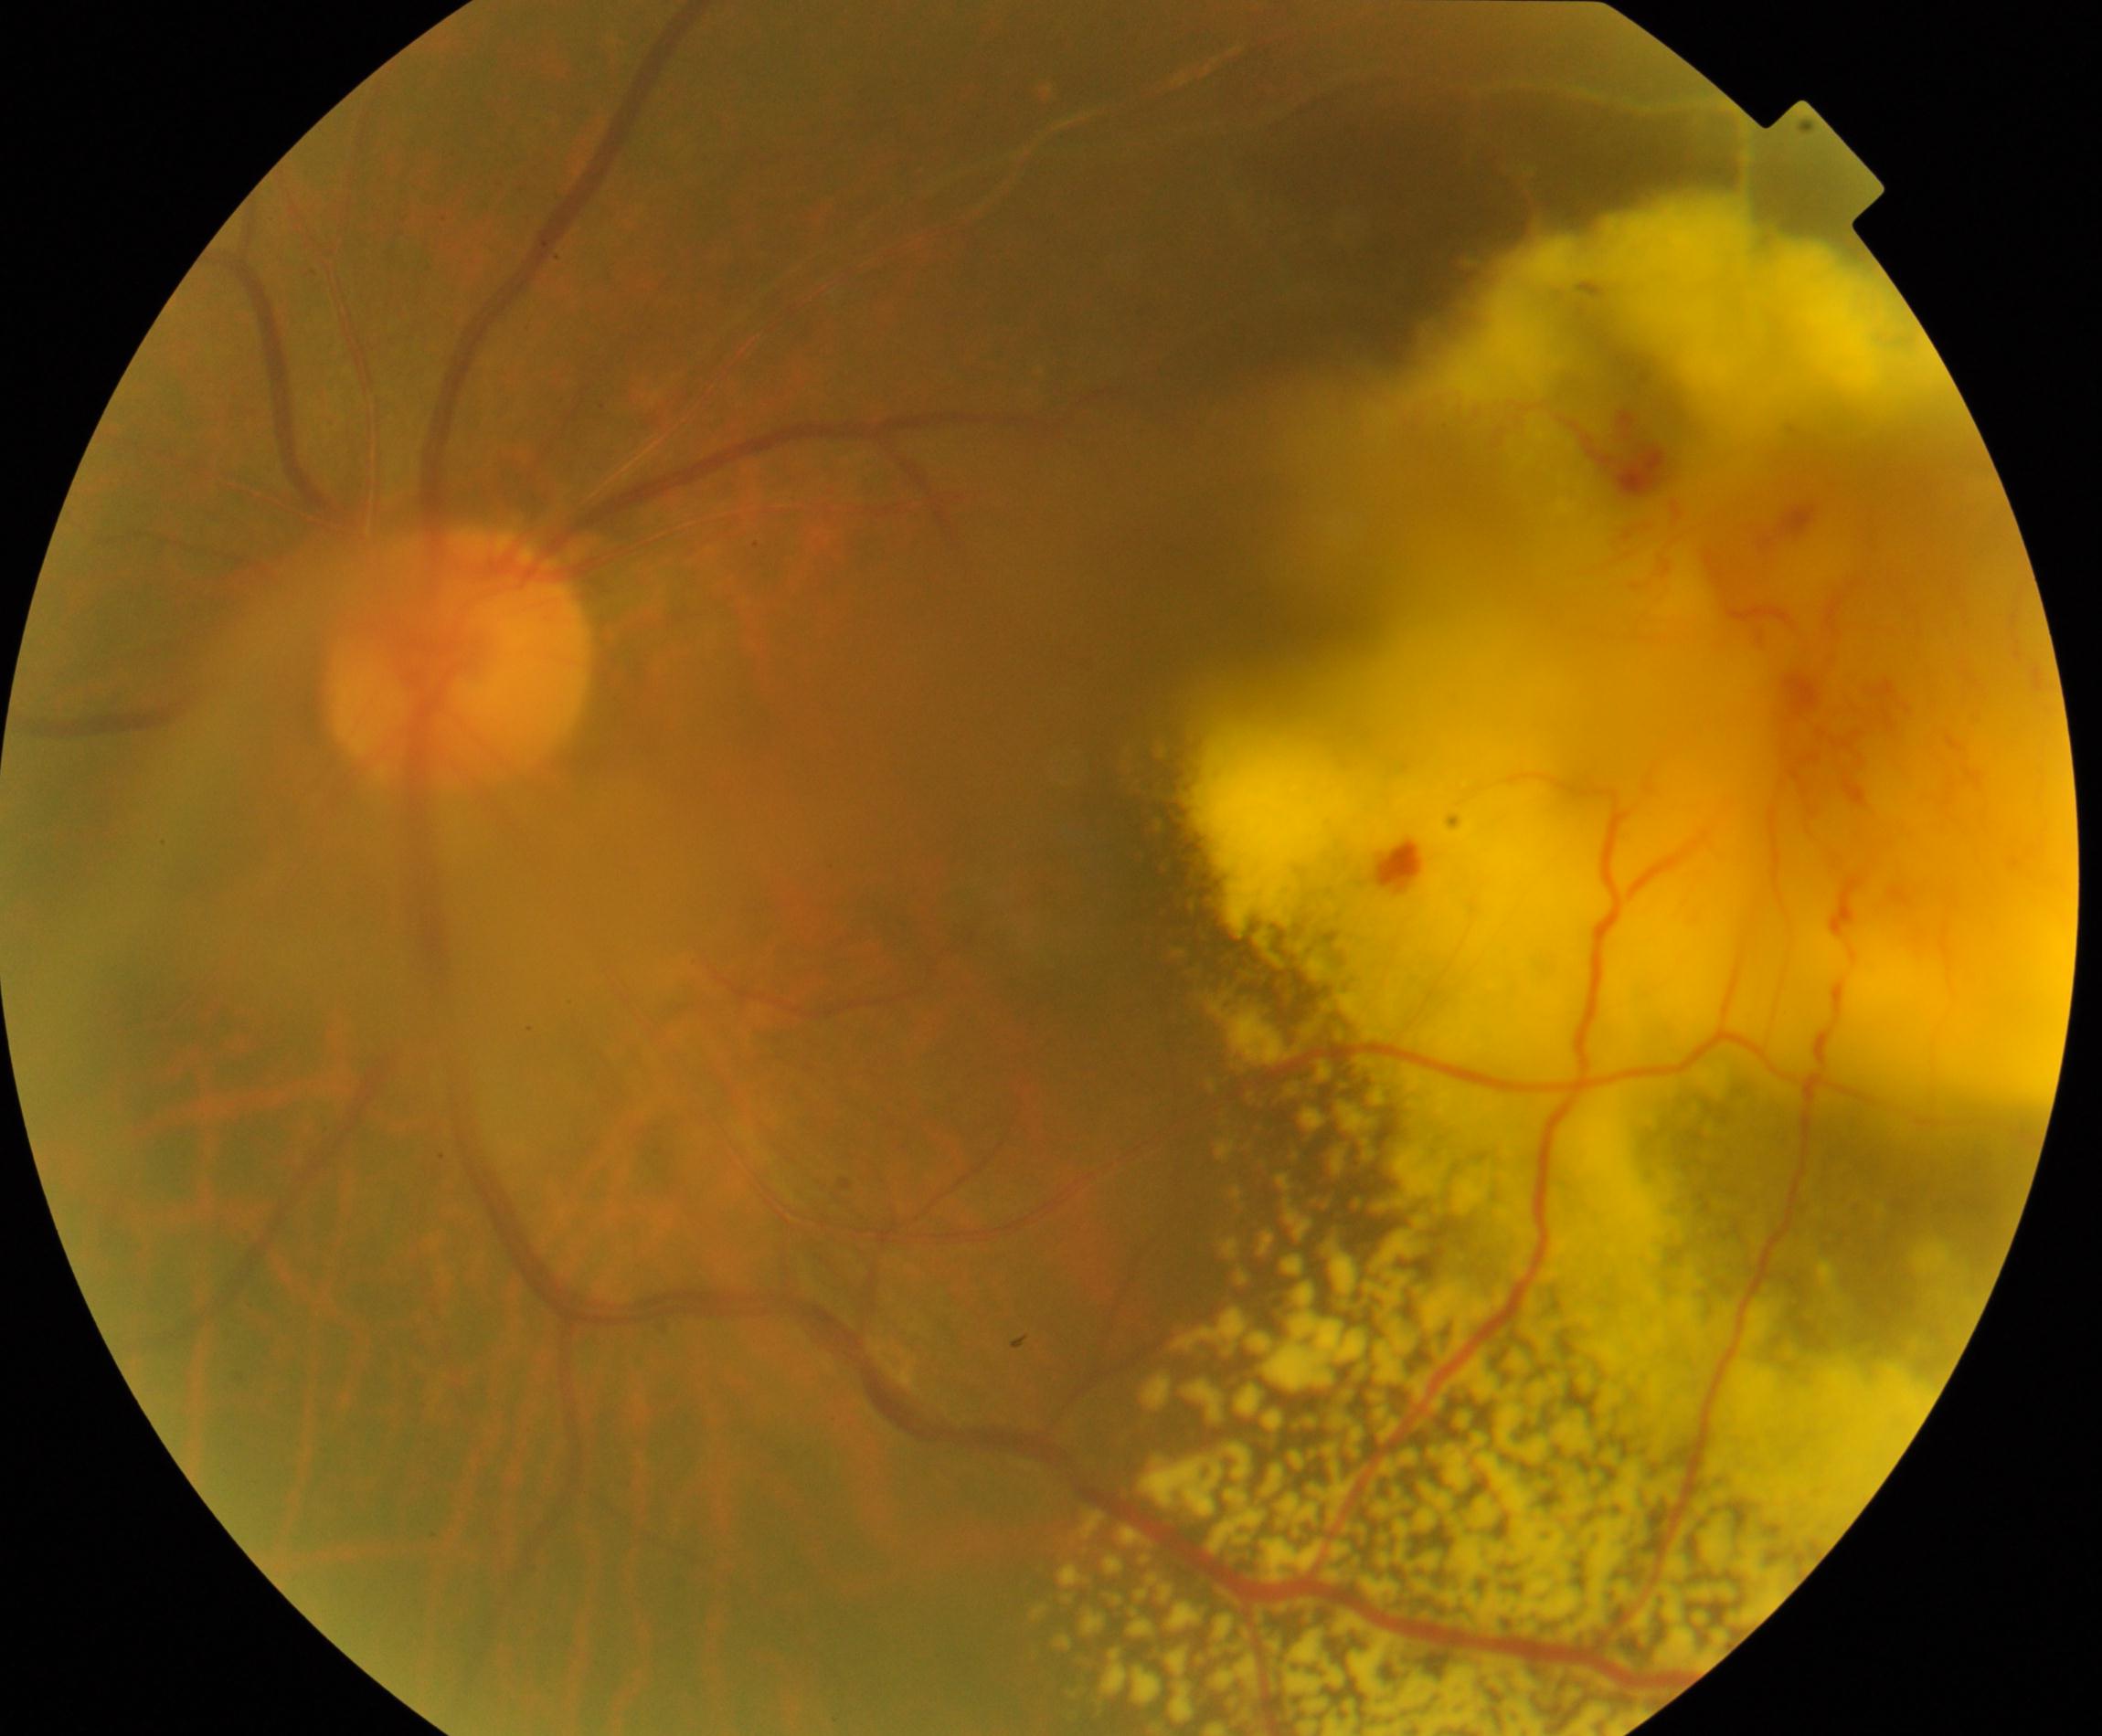

Impression: massive hard exudates.